848 x 848 pixels
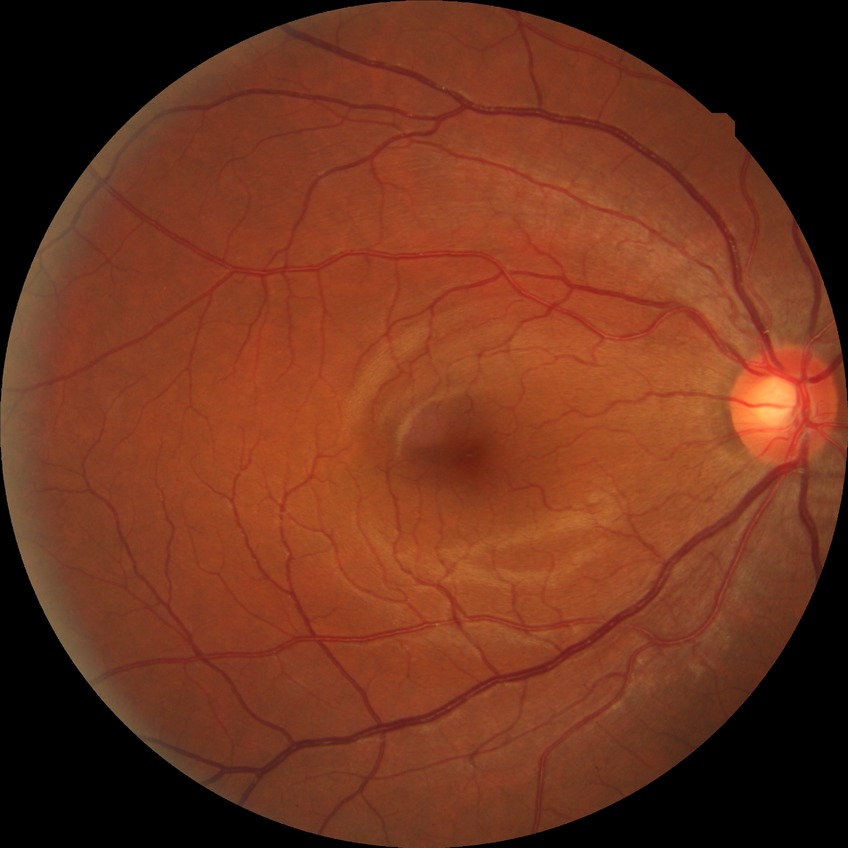

diabetic retinopathy grade = no diabetic retinopathy.